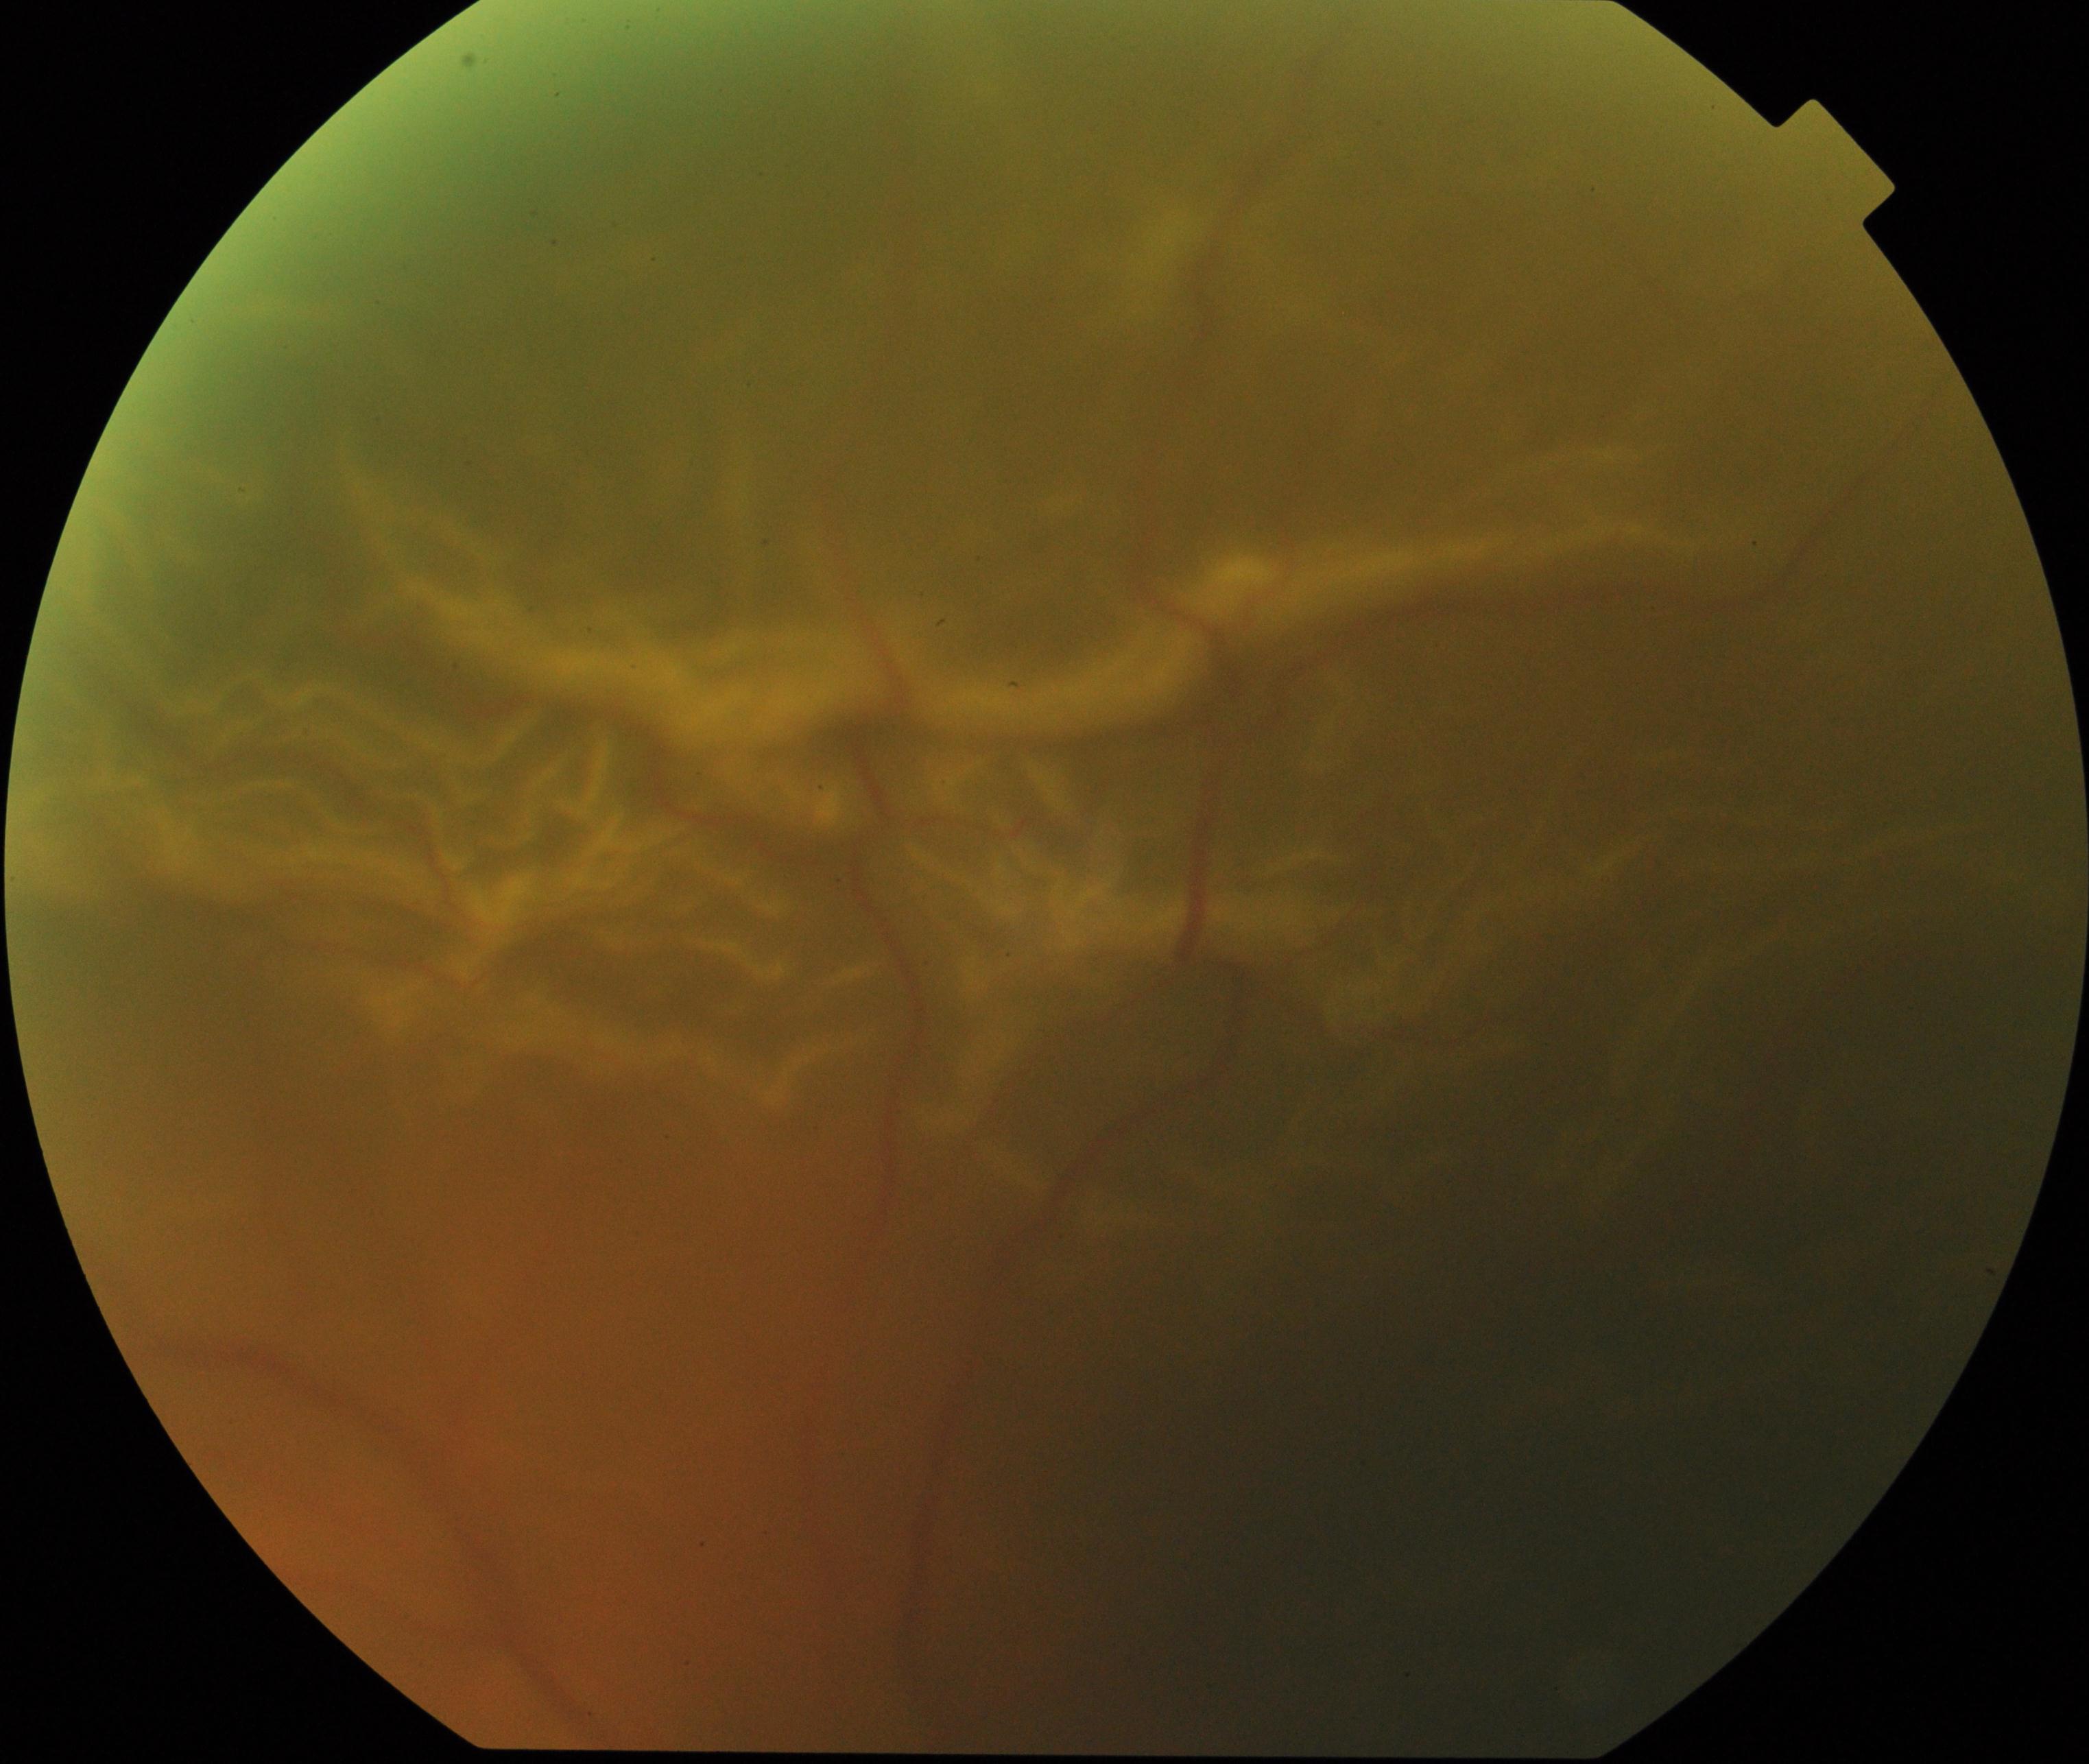

Impression: rhegmatogenous retinal detachment.